45-degree field of view · retinal fundus photograph — 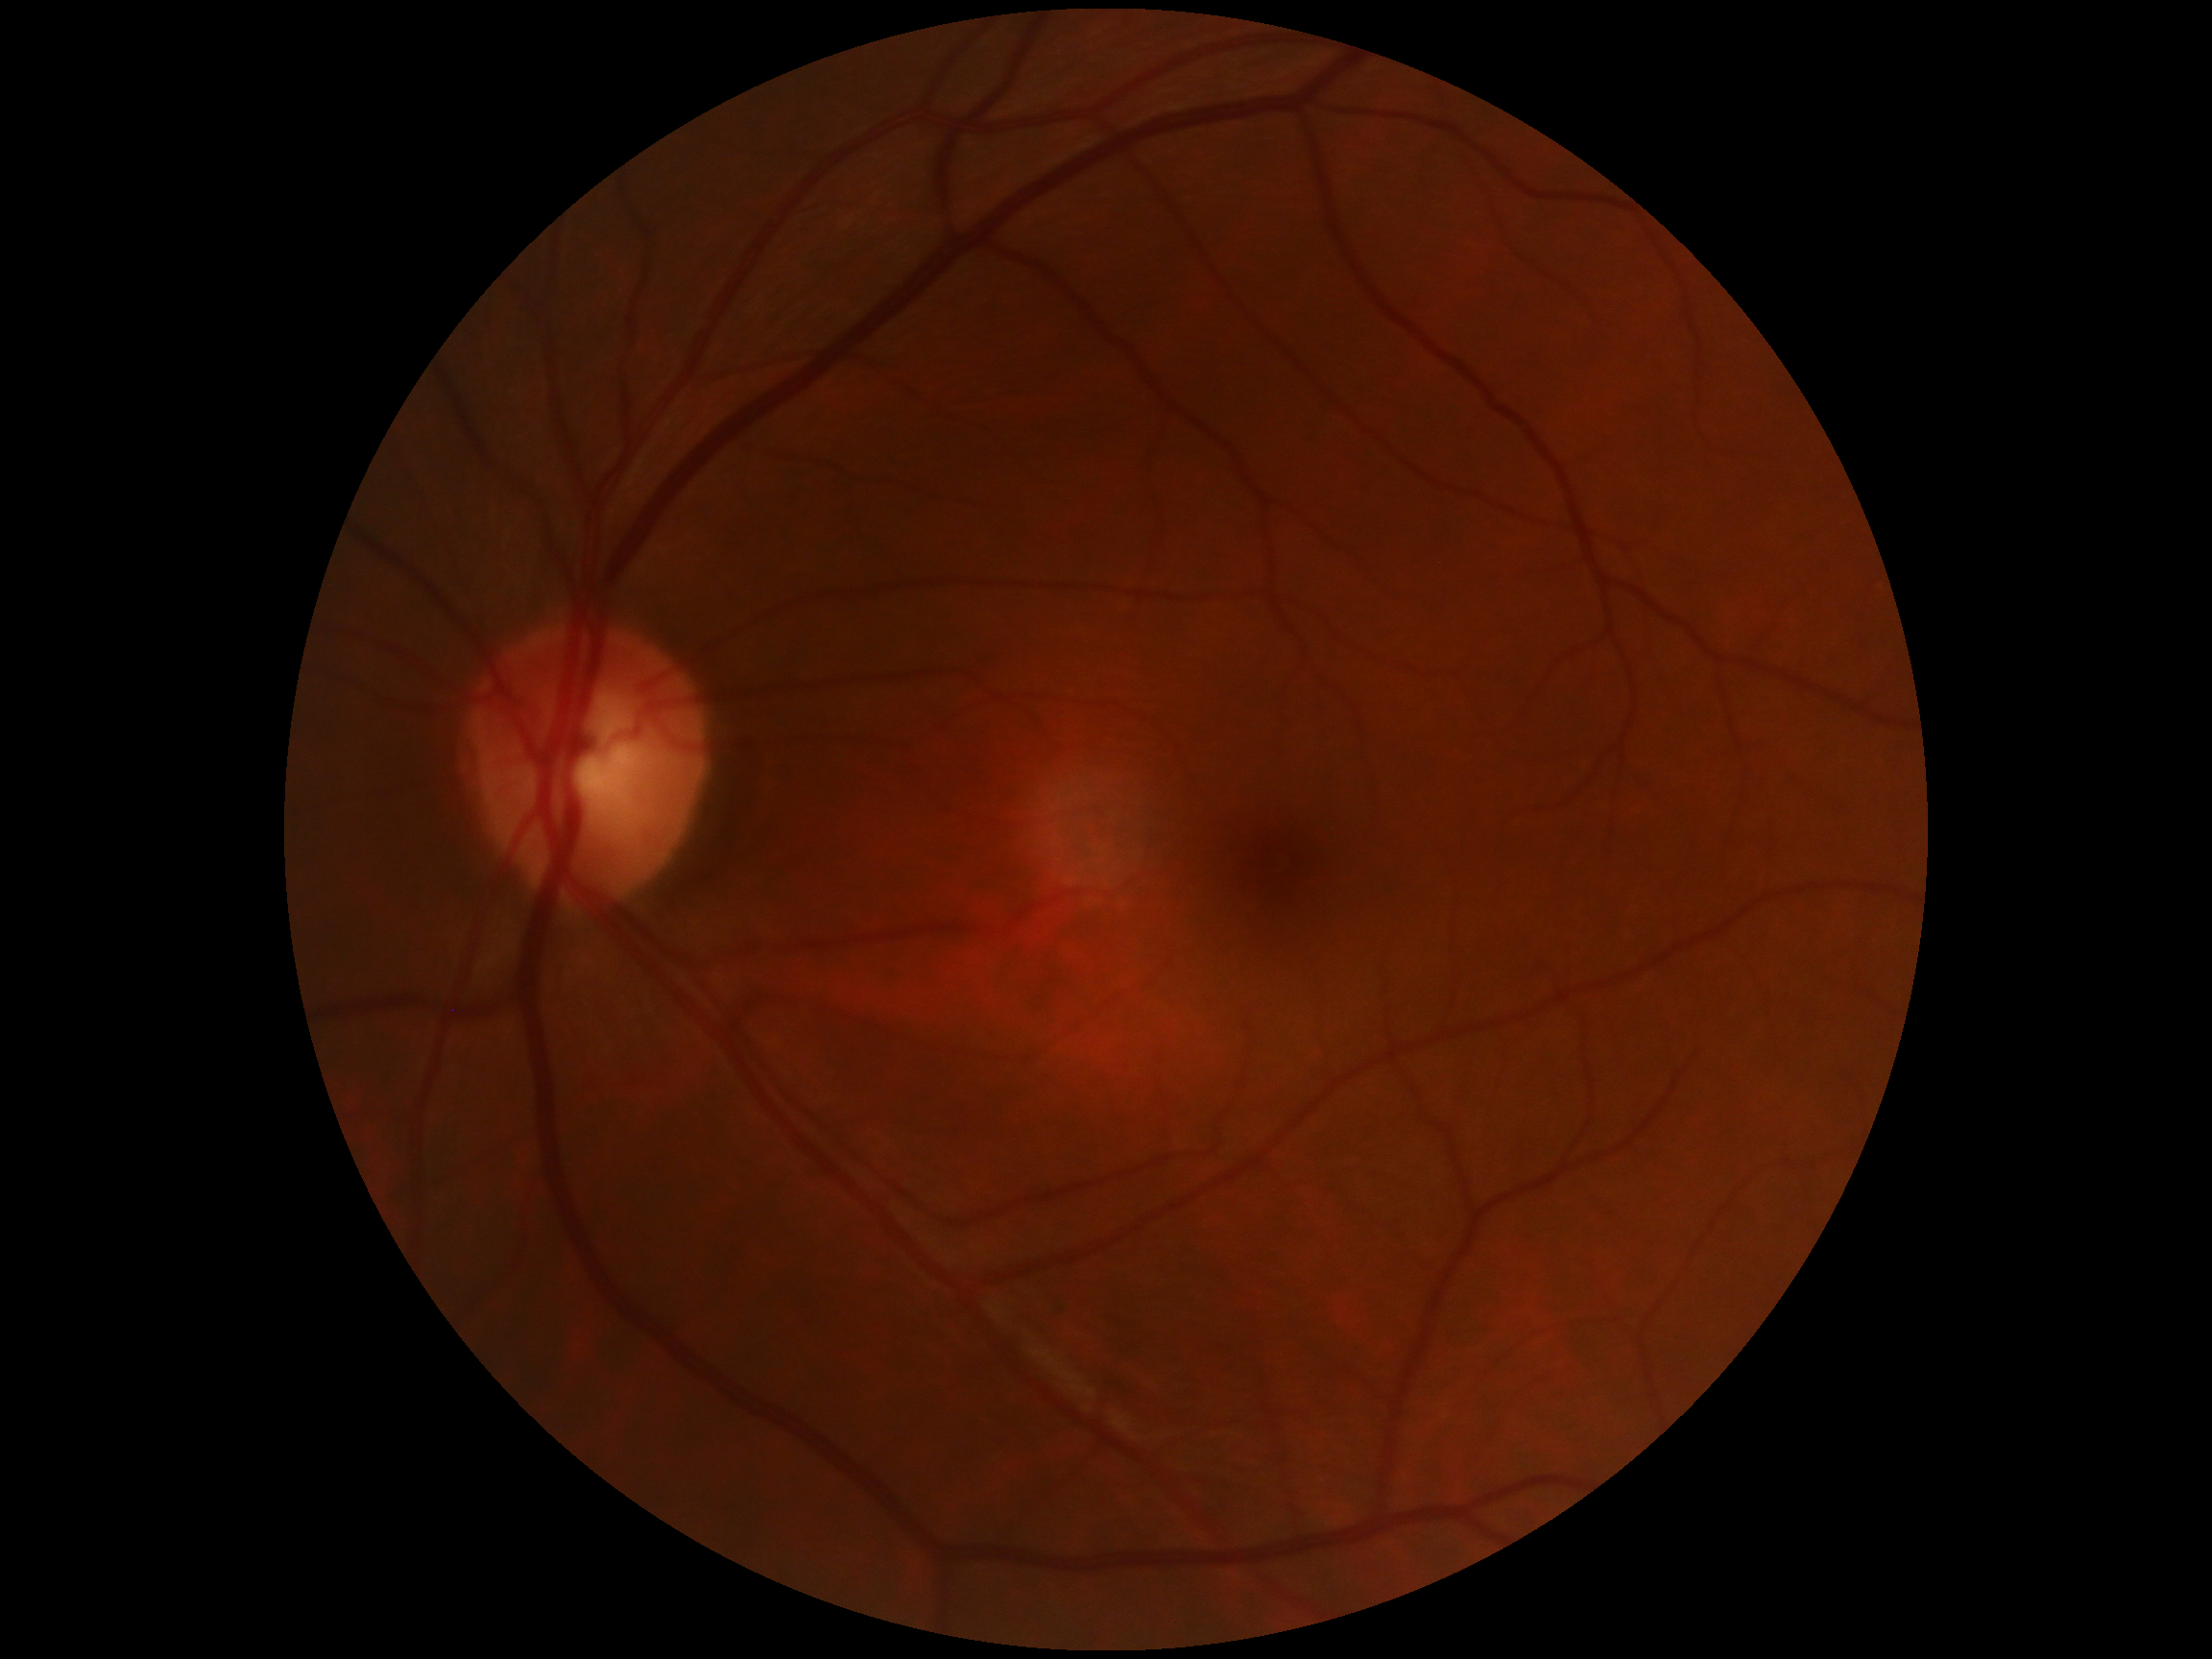
DR: grade 0. No apparent diabetic retinopathy.